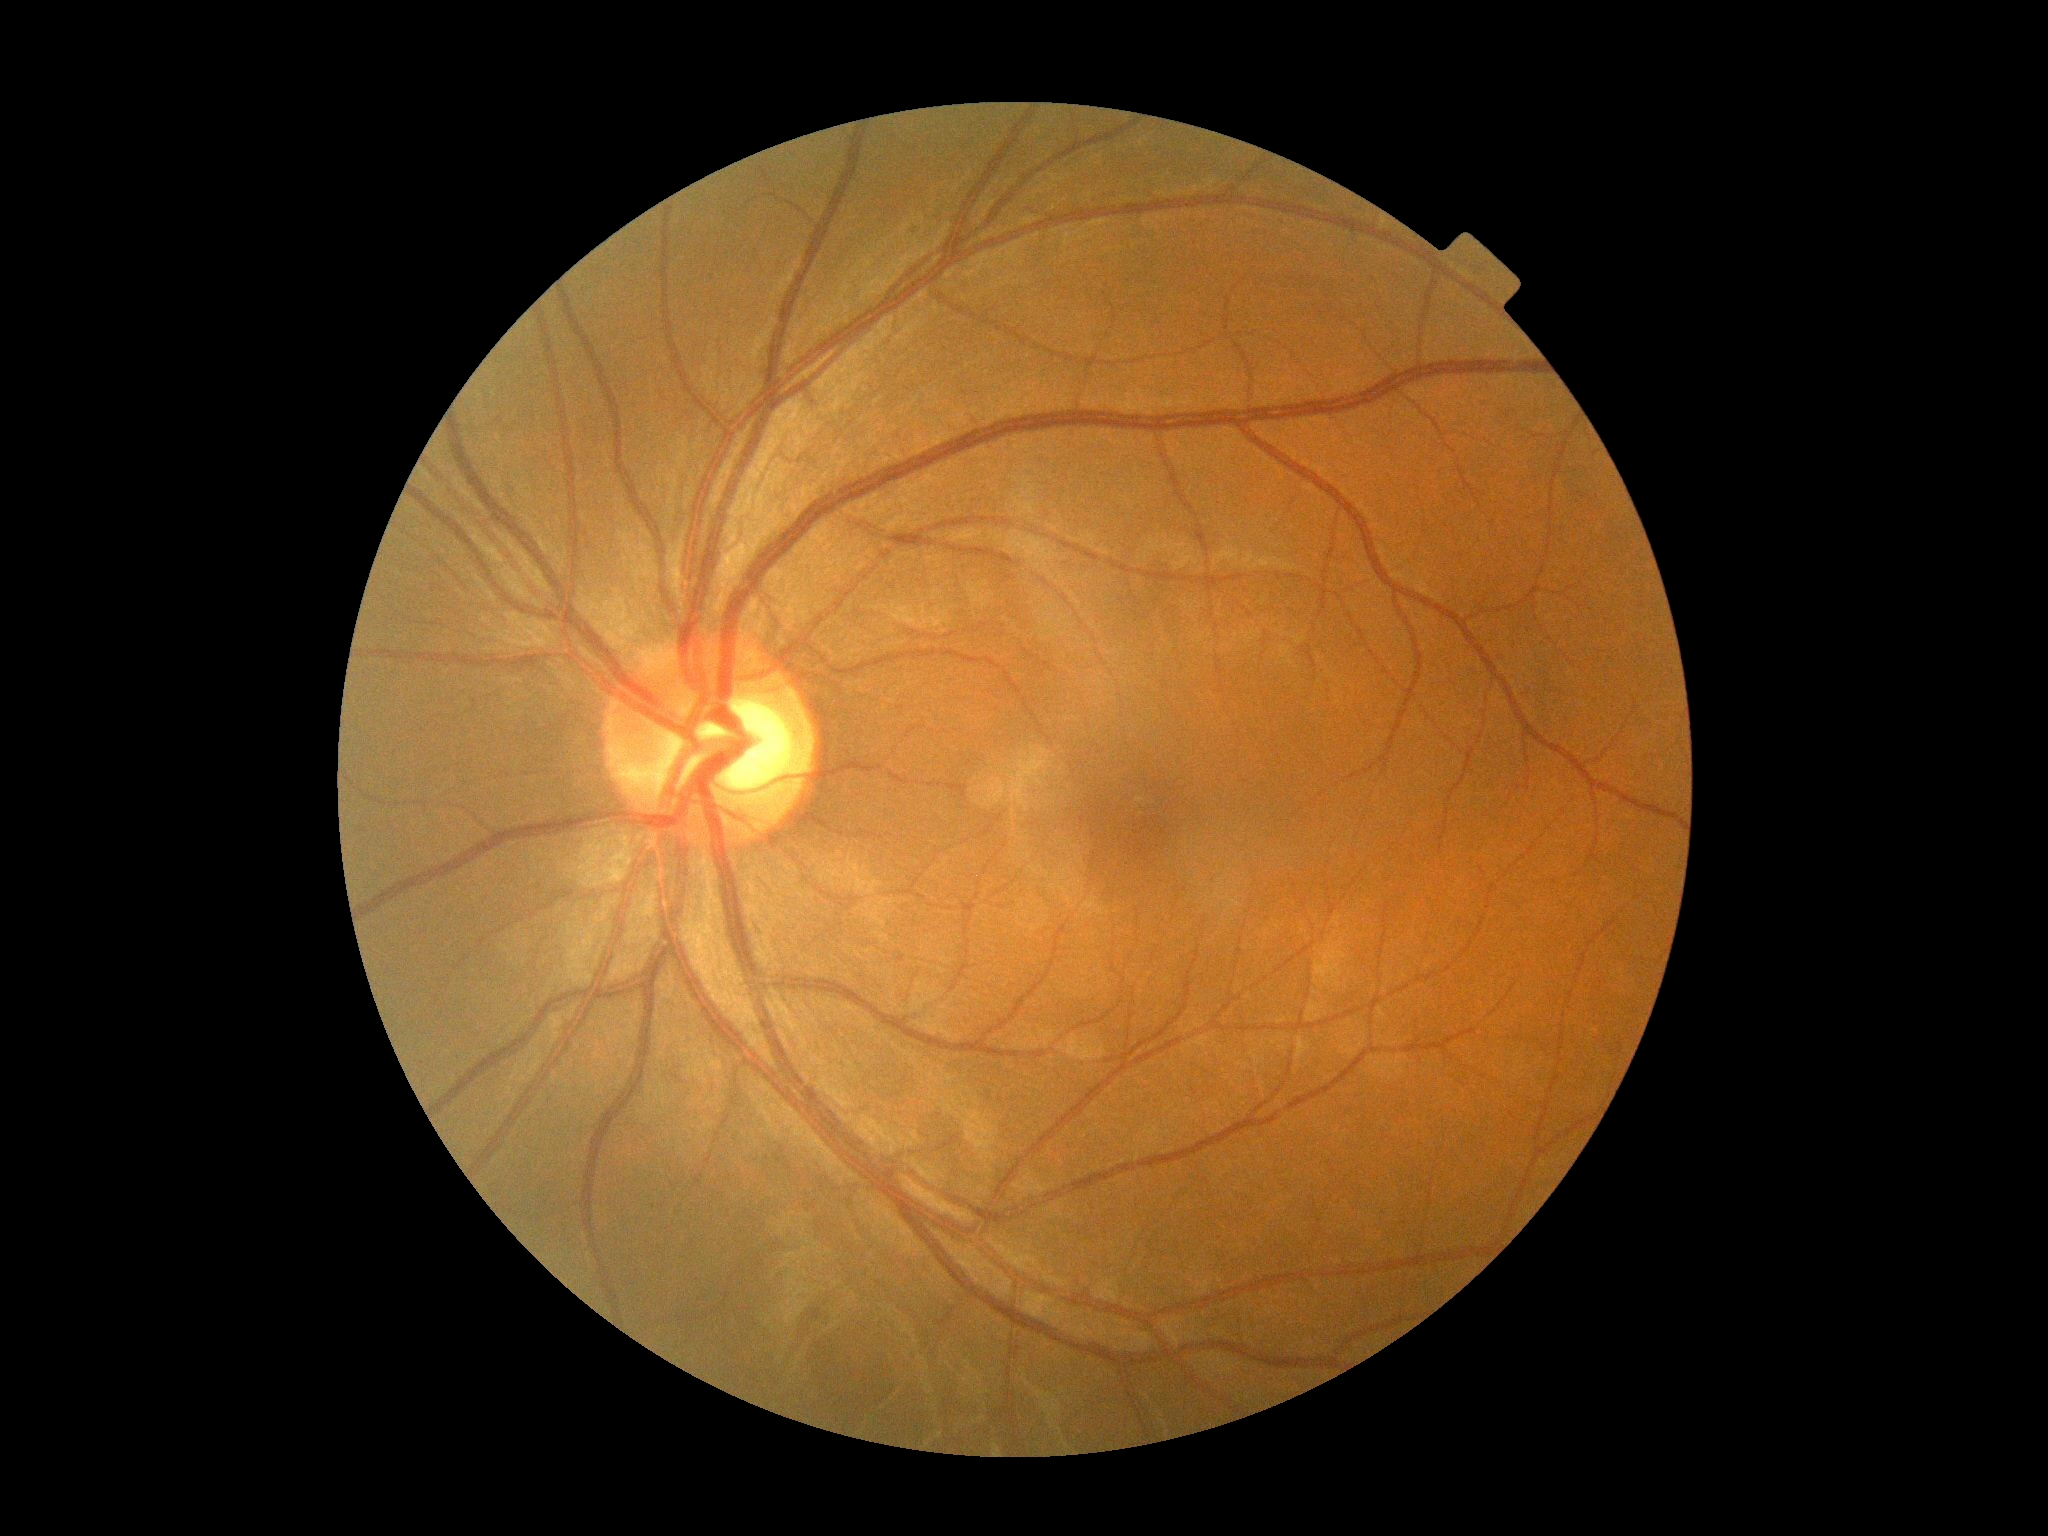
DR is grade 0.